240 x 240 pixels:
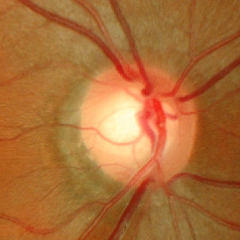

Impression: early glaucomatous optic neuropathy. Defined as glaucomatous retinal nerve fiber layer defects on red-free fundus photography without visual field defects.